Davis DR grading; fundus photo; without pupil dilation:
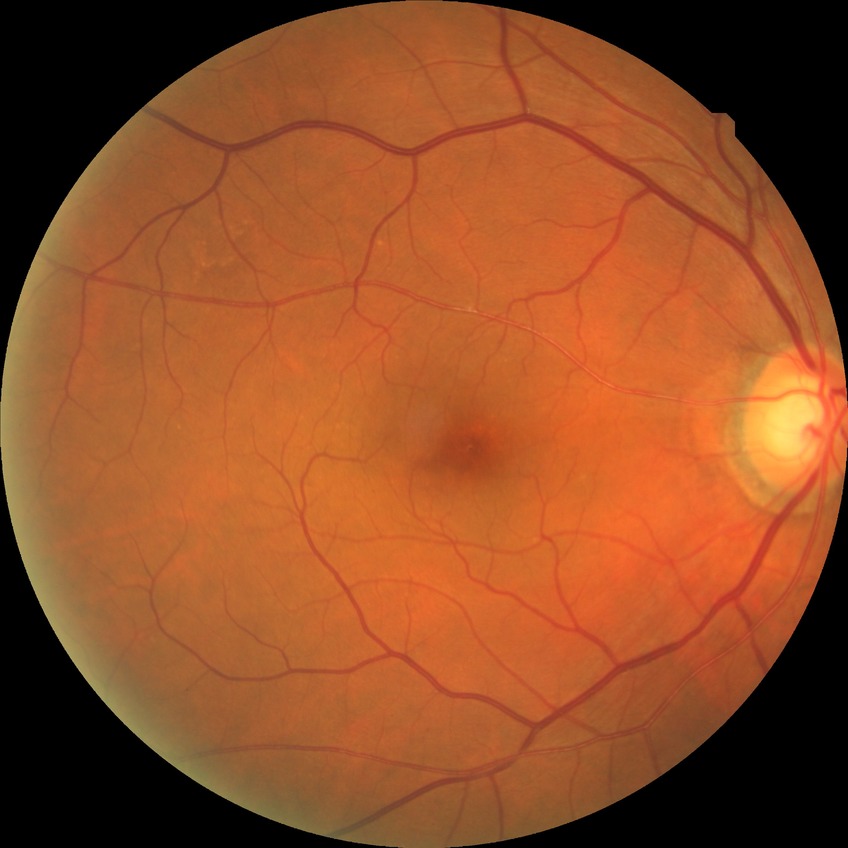 Diabetic retinopathy (DR): no diabetic retinopathy (NDR).